Captured on a Forus 3Nethra Classic:
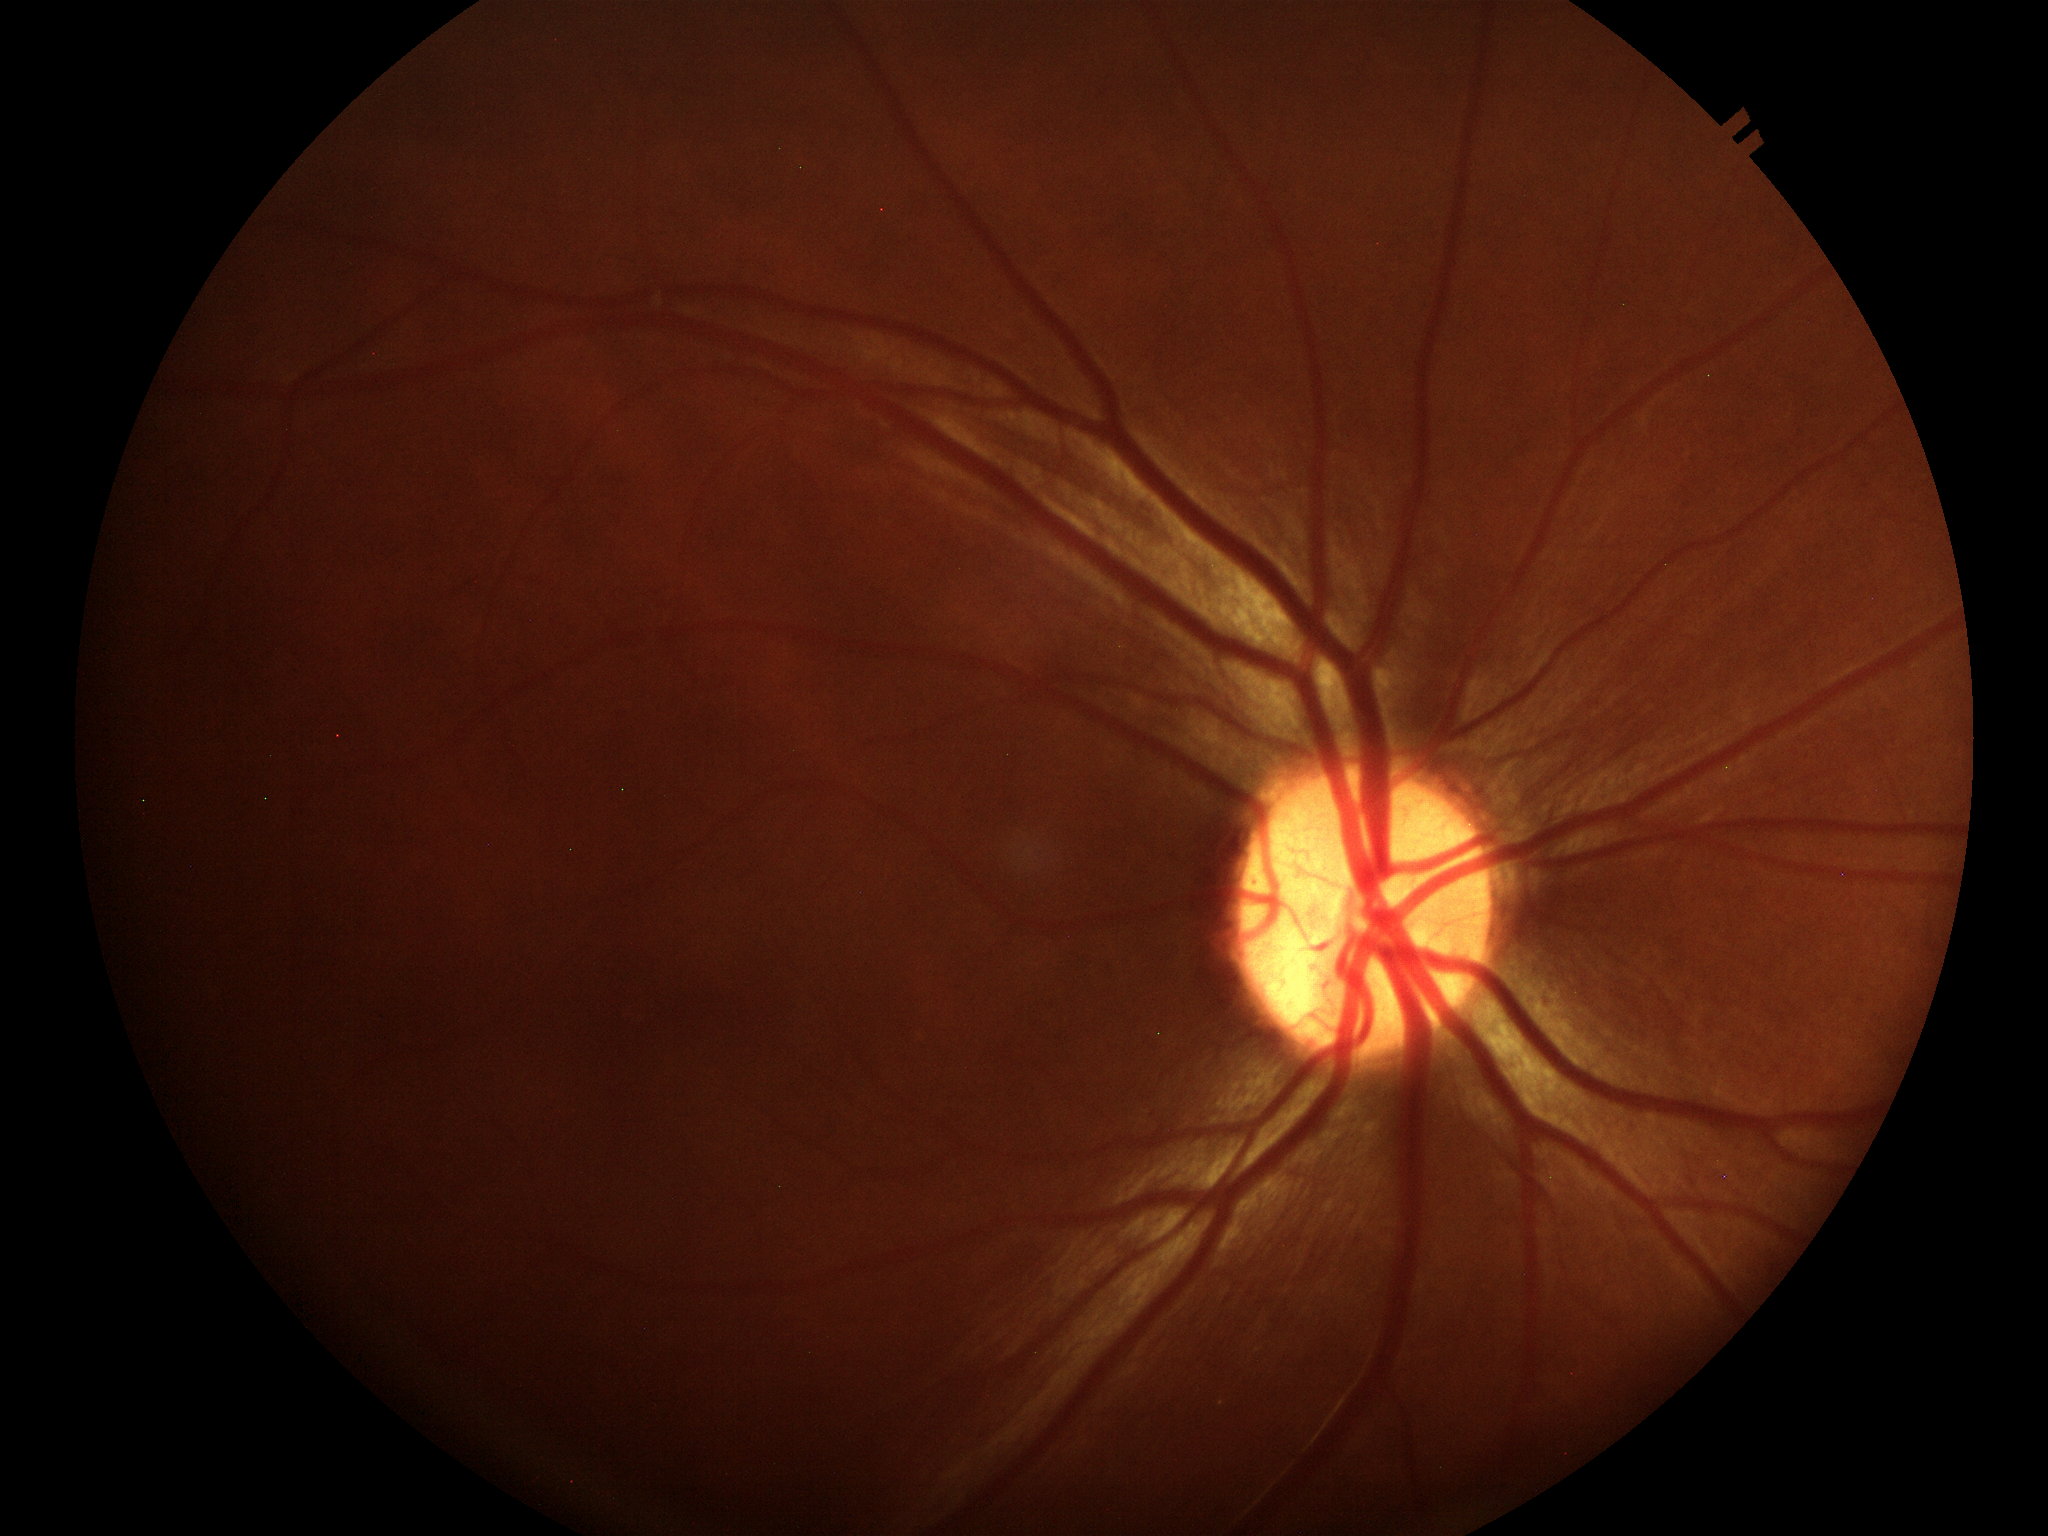 Glaucoma decision: not suspect. Vertical cup-disc ratio (VCDR) is 0.49.